1240 x 1240 pixels; Phoenix ICON wide-field infant fundus image:
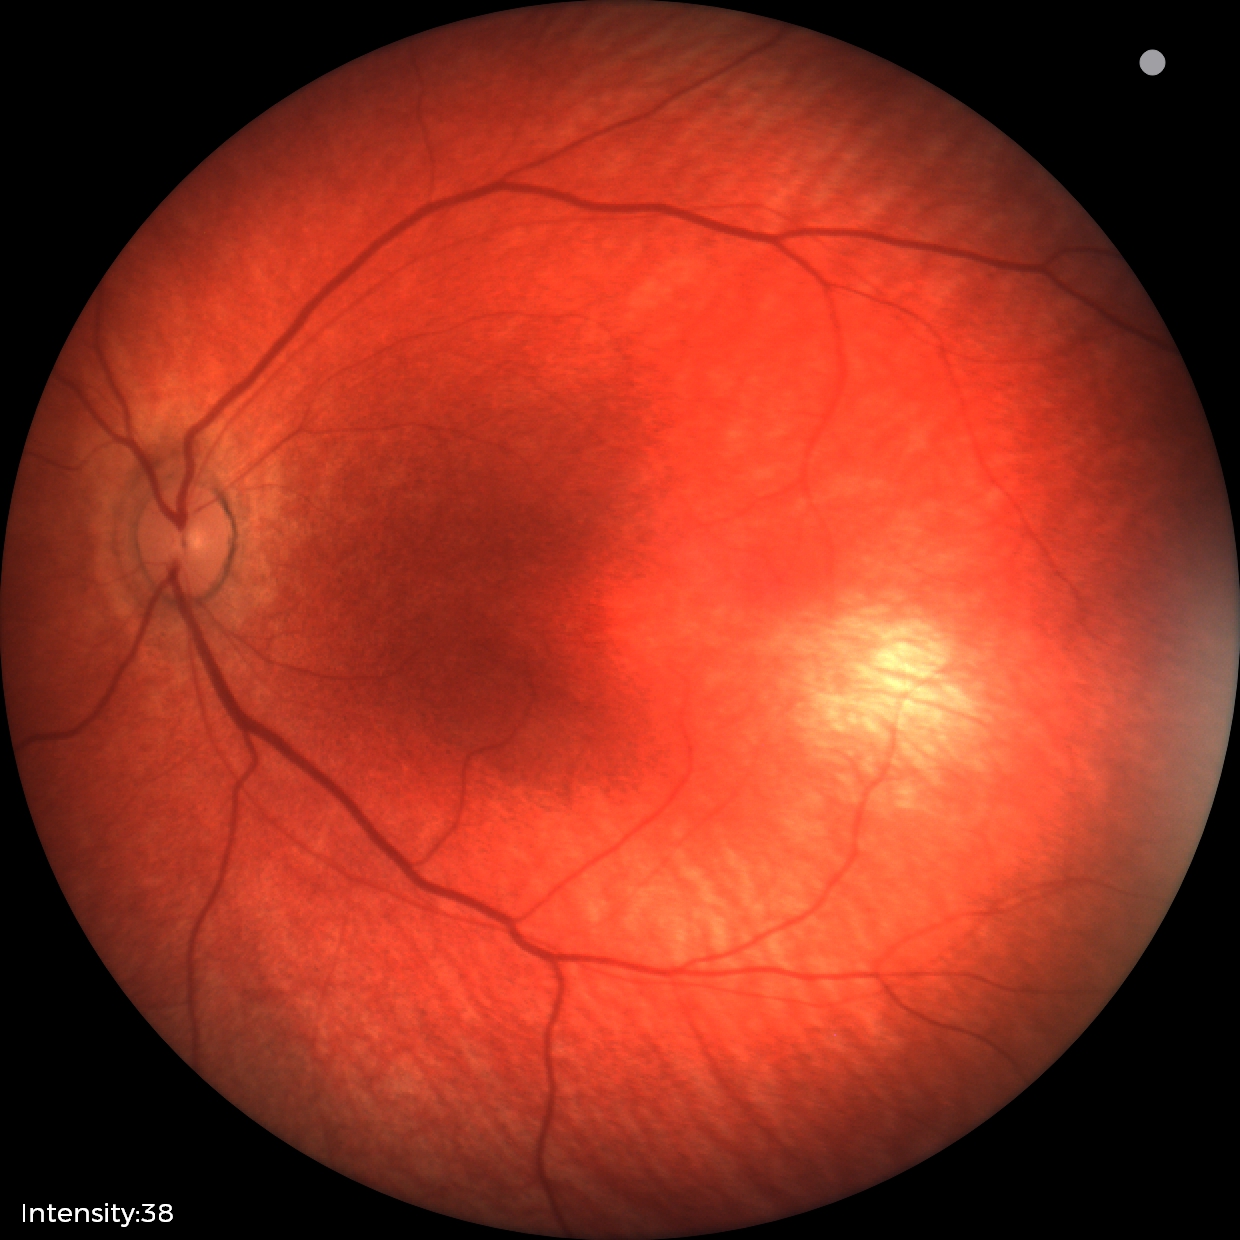

Assessment = physiological